1936 by 1296 pixels: 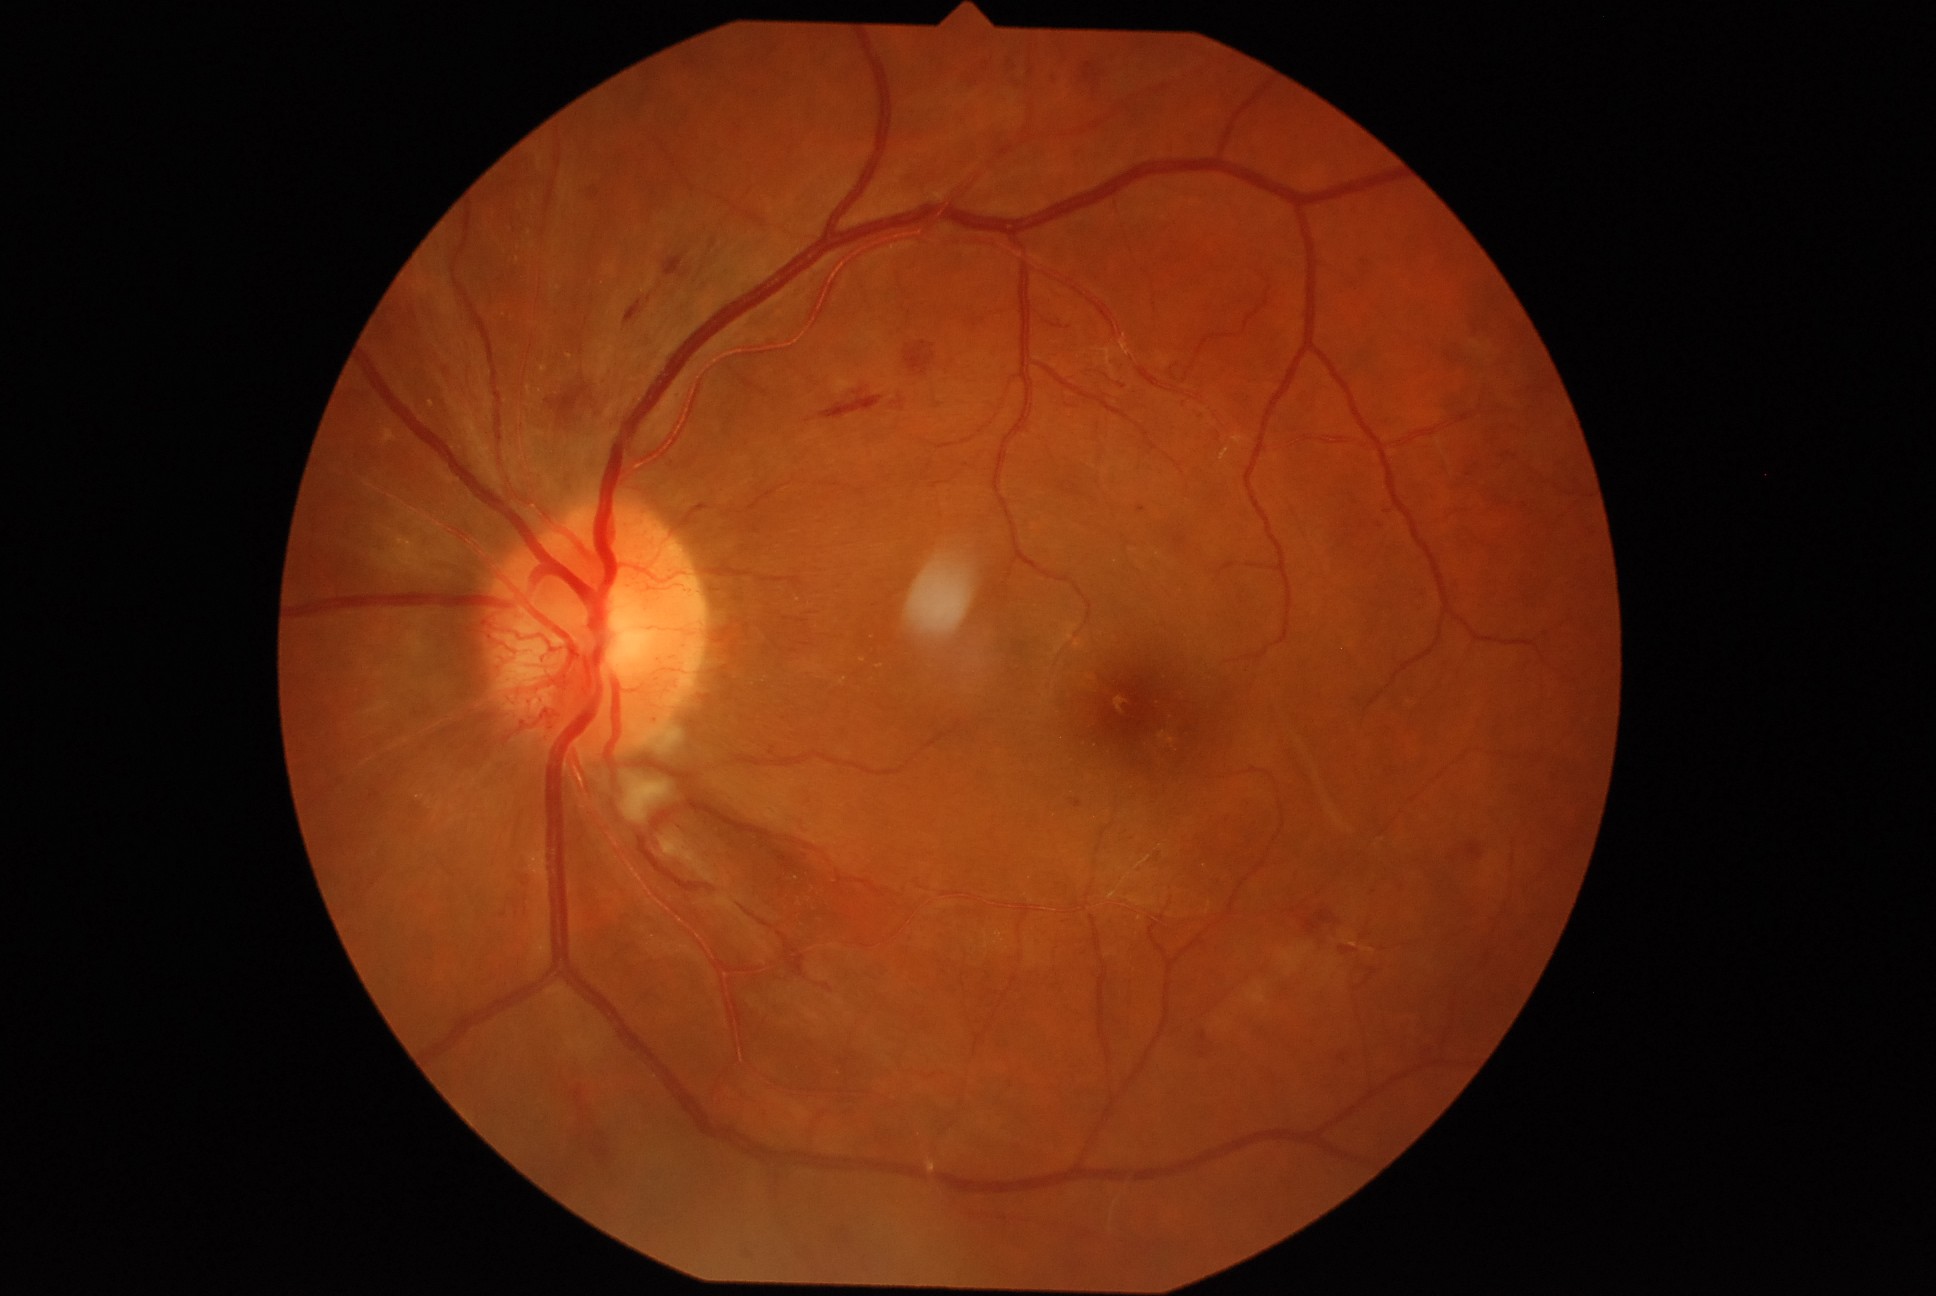 DR is grade 4 (PDR)
Selected lesions:
MAs (continued): l=745, t=1248, r=755, b=1262, l=1137, t=506, r=1147, b=514, l=800, t=850, r=810, b=857, l=1075, t=800, r=1080, b=808, l=1316, t=921, r=1341, b=947
Additional small MAs near x=658, y=719, x=782, y=718, x=1470, y=475, x=680, y=396, x=1388, y=512, x=675, y=460, x=1203, y=1055, x=680, y=828
EXs (continued): l=839, t=678, r=847, b=686
Additional small EXs near x=518, y=248, x=544, y=369, x=570, y=357, x=423, y=797, x=530, y=234, x=863, y=660, x=533, y=246, x=799, y=601, x=518, y=260, x=880, y=667, x=431, y=405
HEs (continued): l=1084, t=63, r=1096, b=81, l=663, t=256, r=691, b=280, l=1466, t=842, r=1483, b=862, l=776, t=578, r=804, b=587, l=1006, t=56, r=1017, b=77, l=519, t=874, r=530, b=887, l=1201, t=1033, r=1206, b=1043, l=576, t=1092, r=613, b=1180, l=546, t=385, r=593, b=423, l=584, t=185, r=600, b=198
Additional small HEs near x=749, y=1255
SEs: l=650, t=721, r=684, b=755, l=616, t=765, r=672, b=825